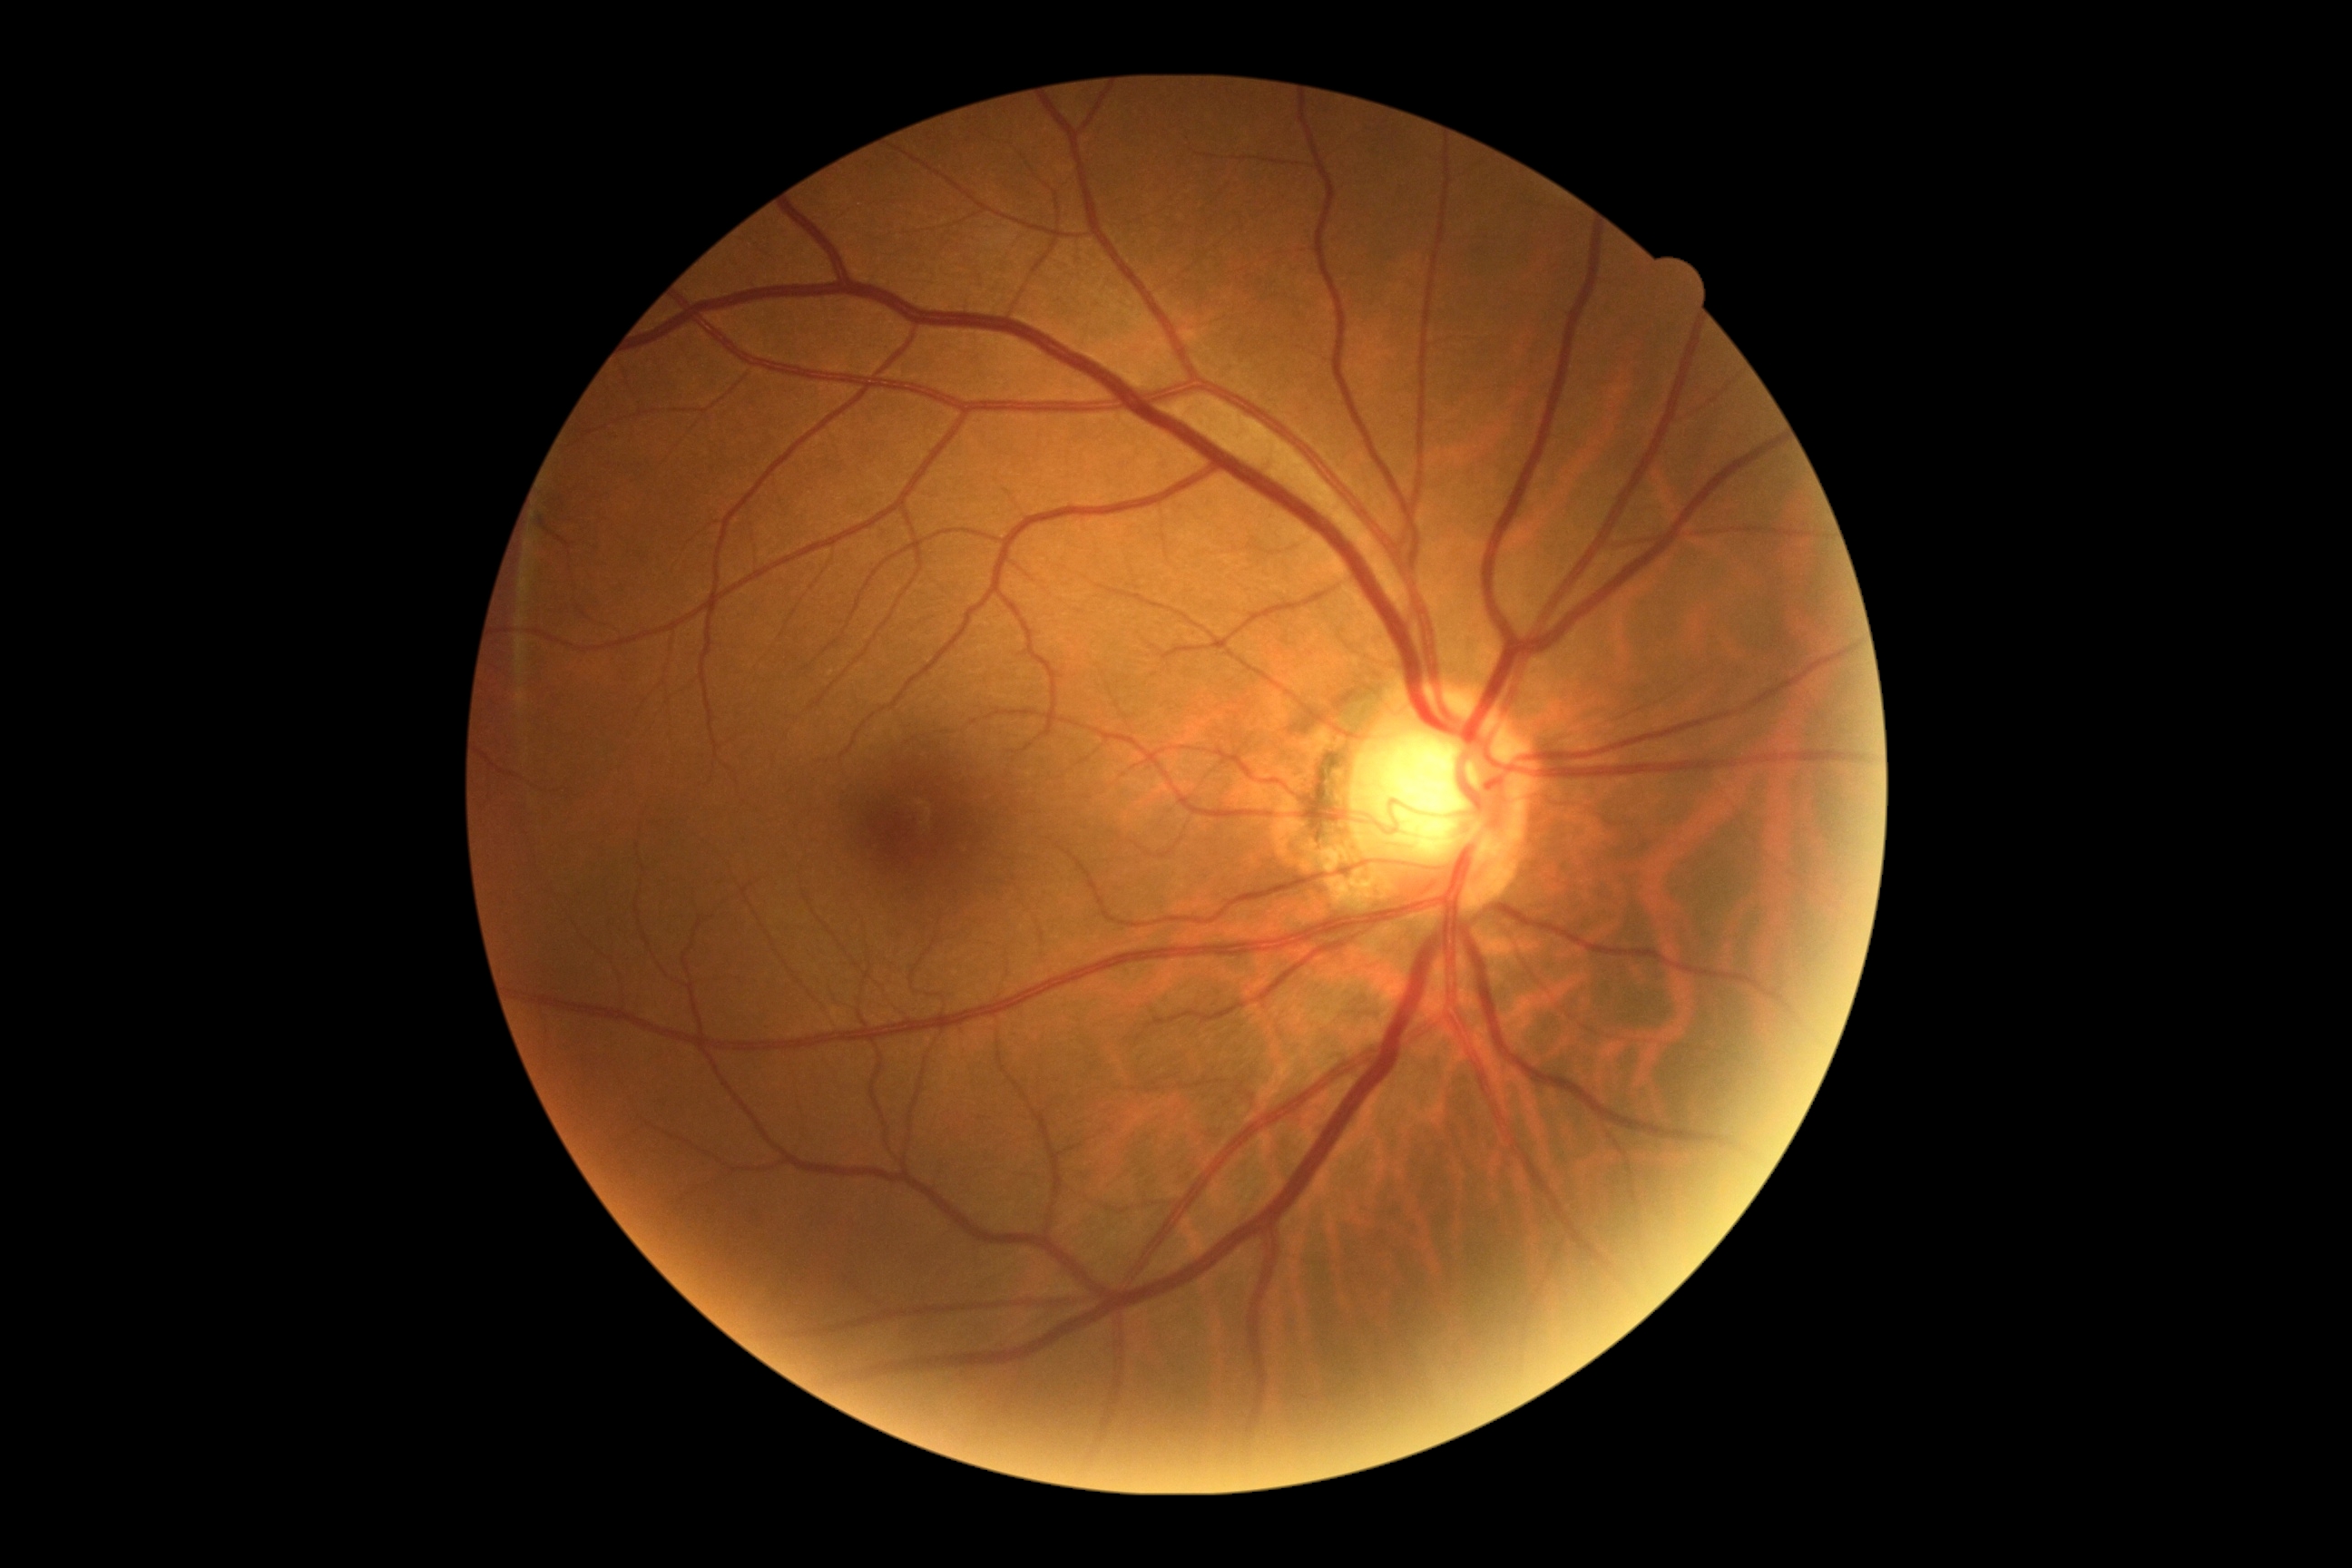
Annotations:
– DR stage: 0